848x848. Without pupil dilation. Acquired with a NIDEK AFC-230. 45 degree fundus photograph — 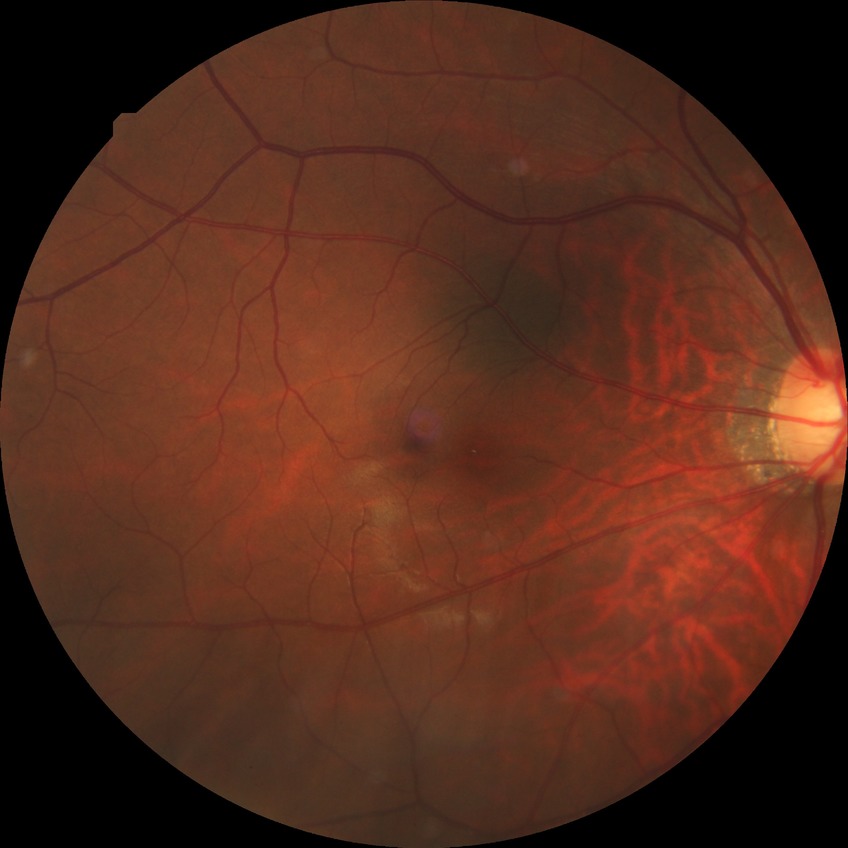

{"davis_grade": "no diabetic retinopathy (NDR)"}